45-degree field of view, retinal fundus photograph
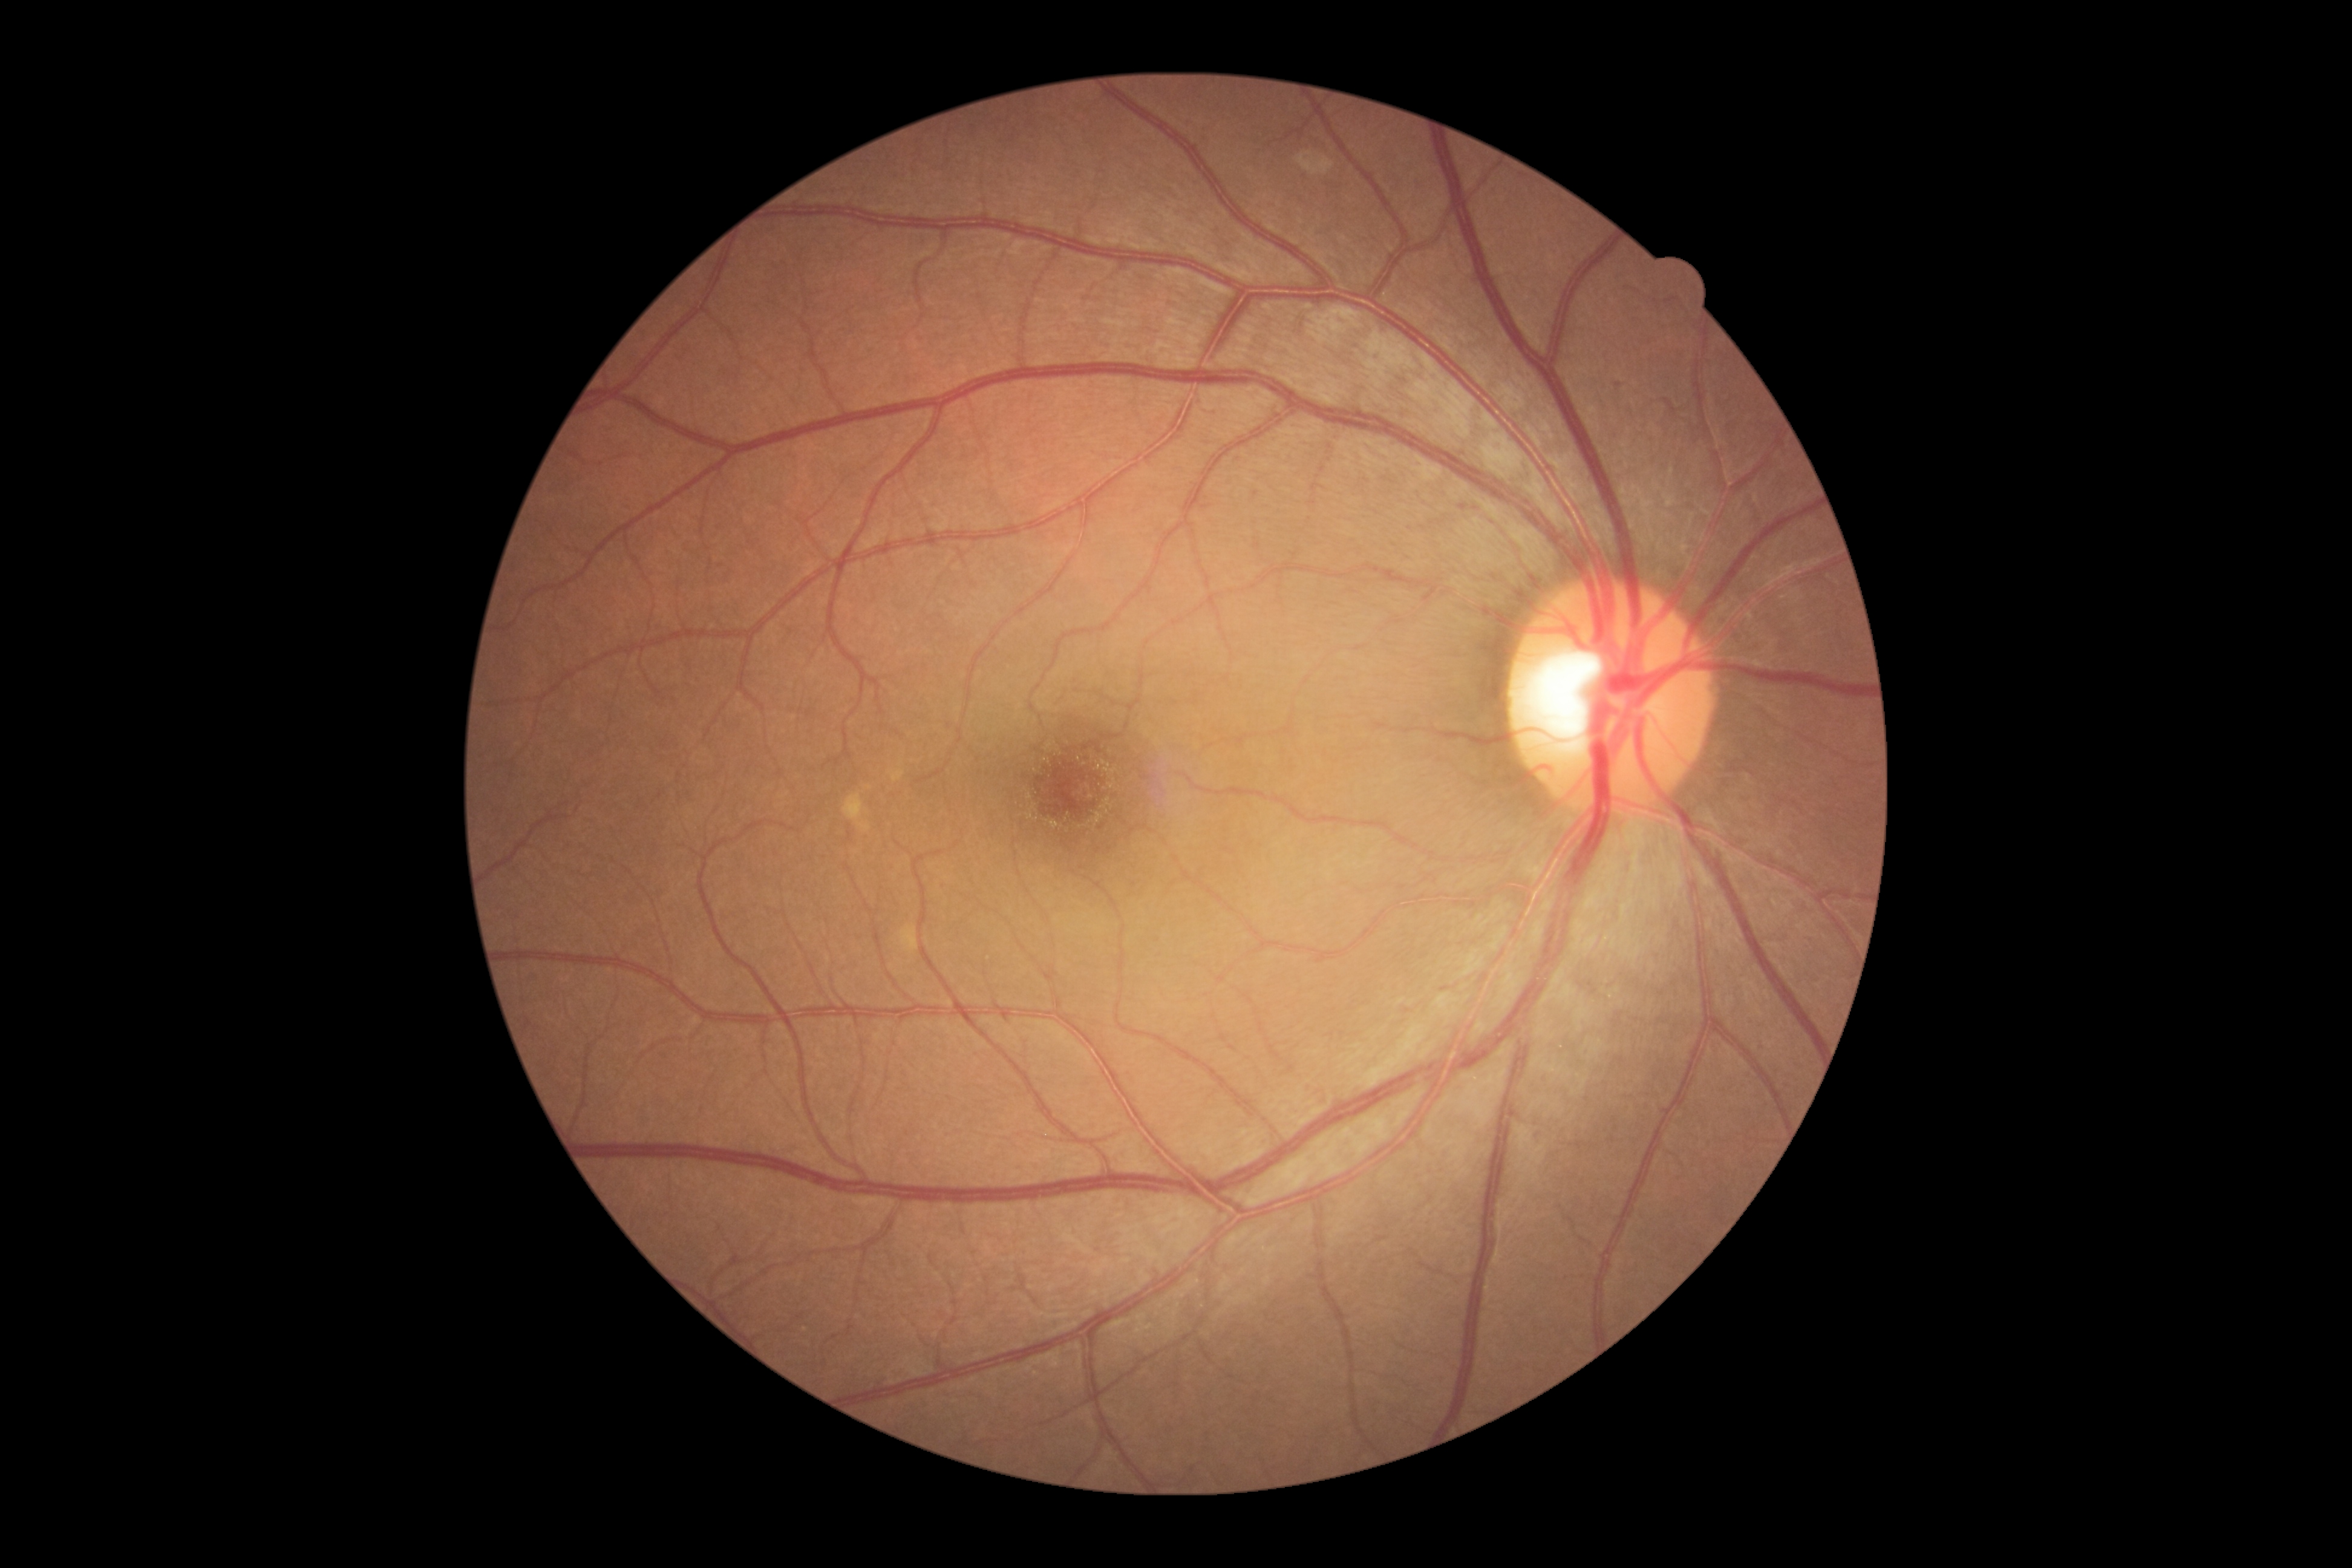

dr_grade: no apparent diabetic retinopathy (grade 0)
dr_impression: no apparent DR